1932x1932, fundus photo
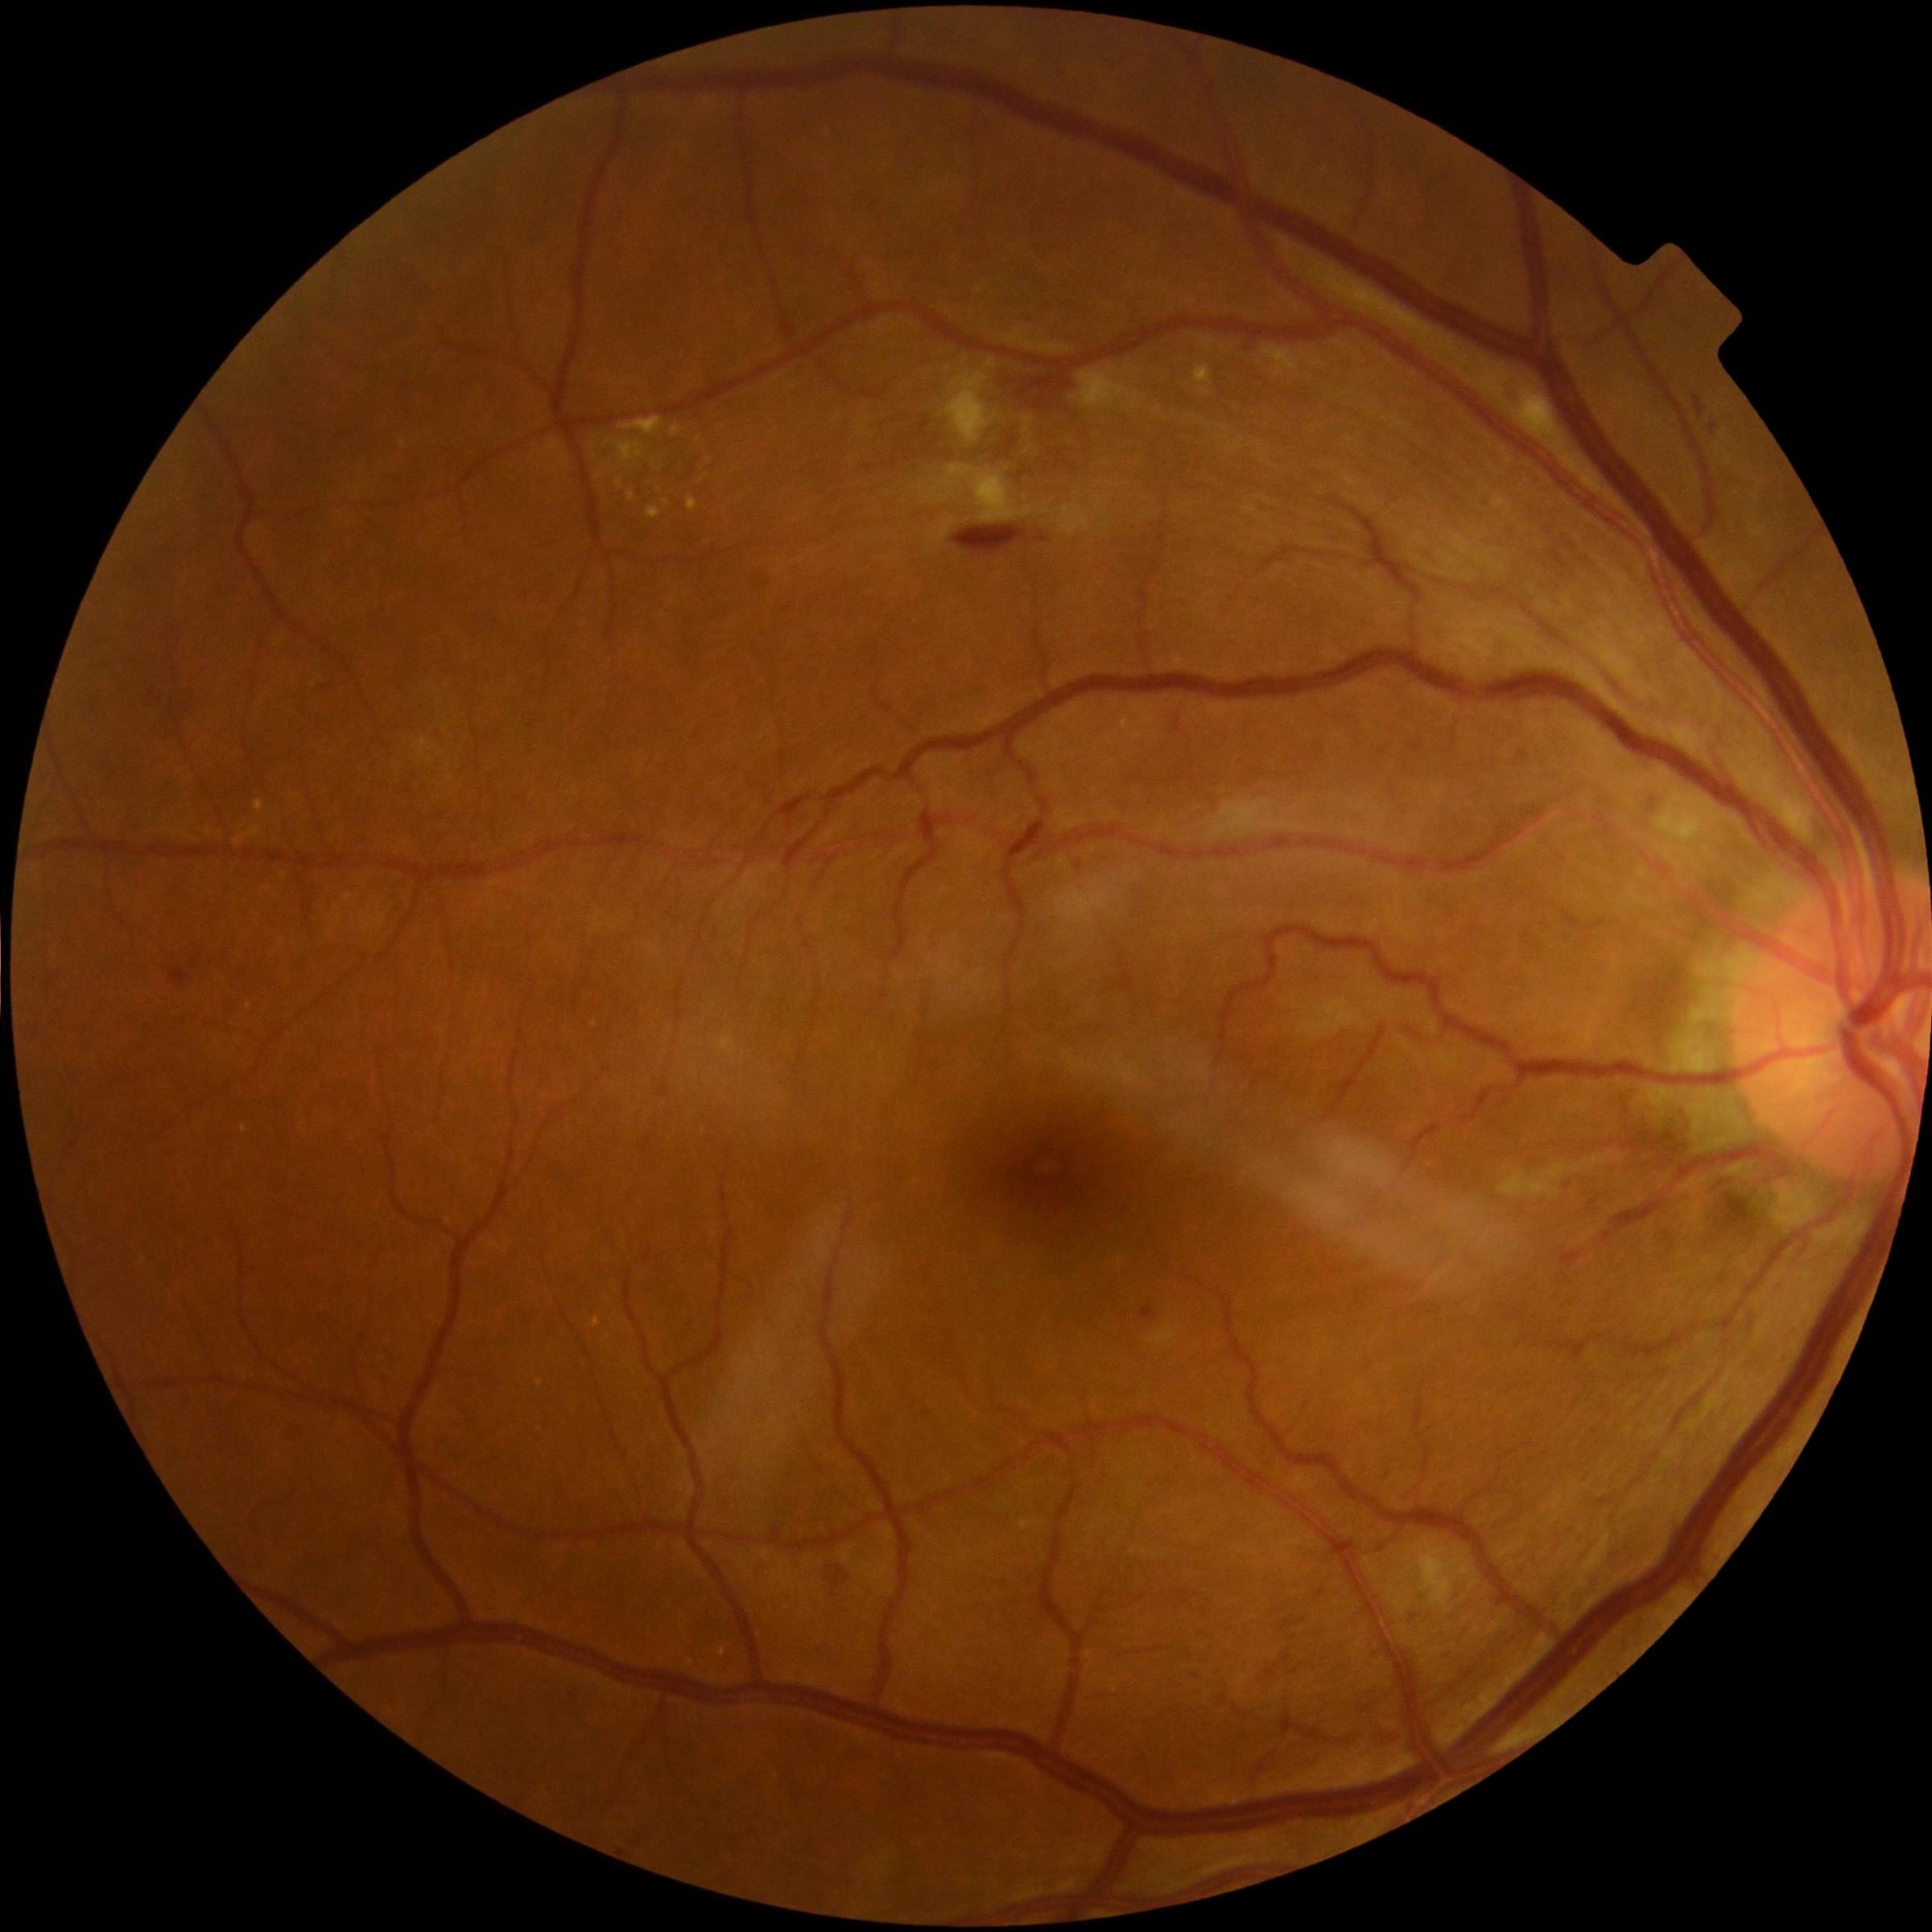
Diabetic retinopathy severity is moderate NPDR (grade 2) — more than just microaneurysms but less than severe NPDR.